CFP, 45 degree fundus photograph, Davis DR grading — 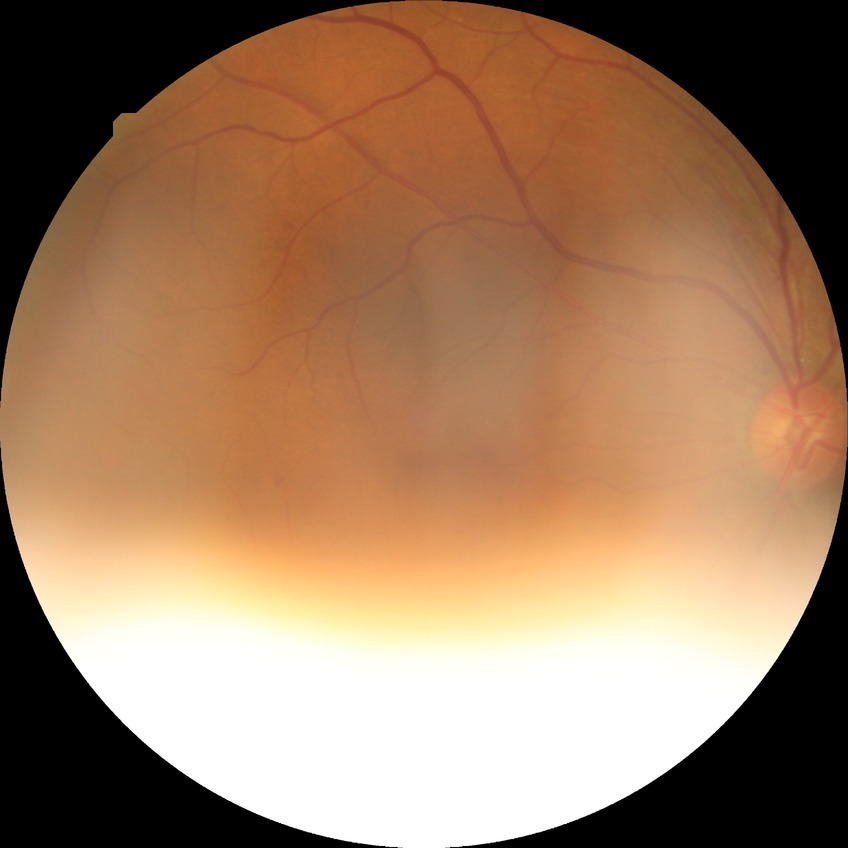

Diabetic retinopathy (DR): SDR (simple diabetic retinopathy).